45° field of view, NIDEK AFC-230, no pharmacologic dilation, 848x848: 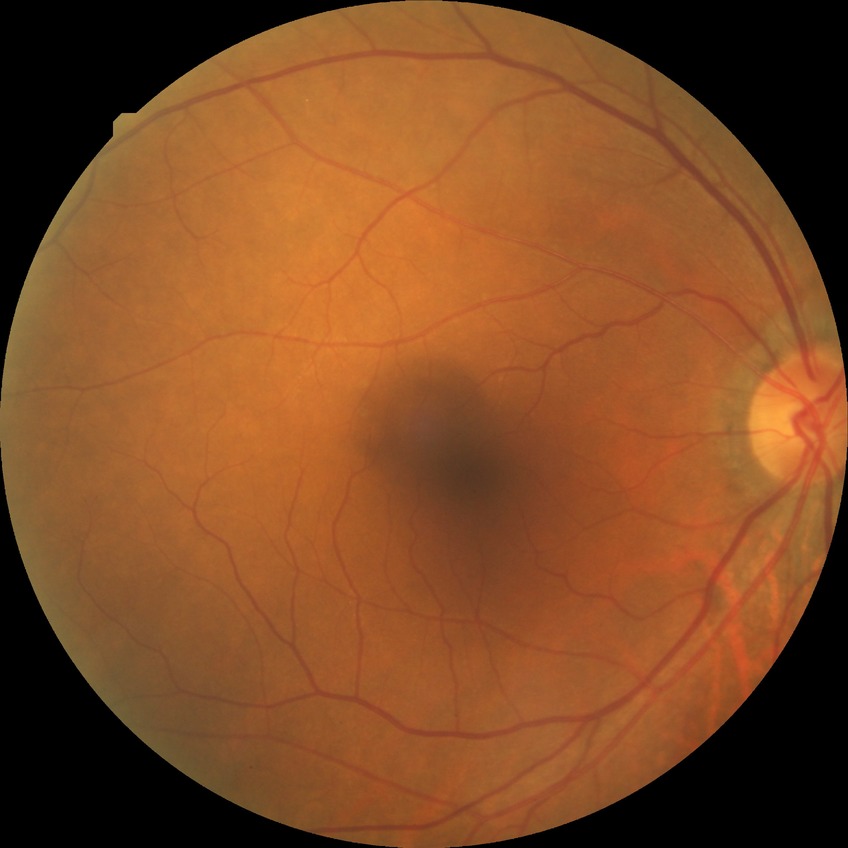
Diabetic retinopathy stage: no diabetic retinopathy.